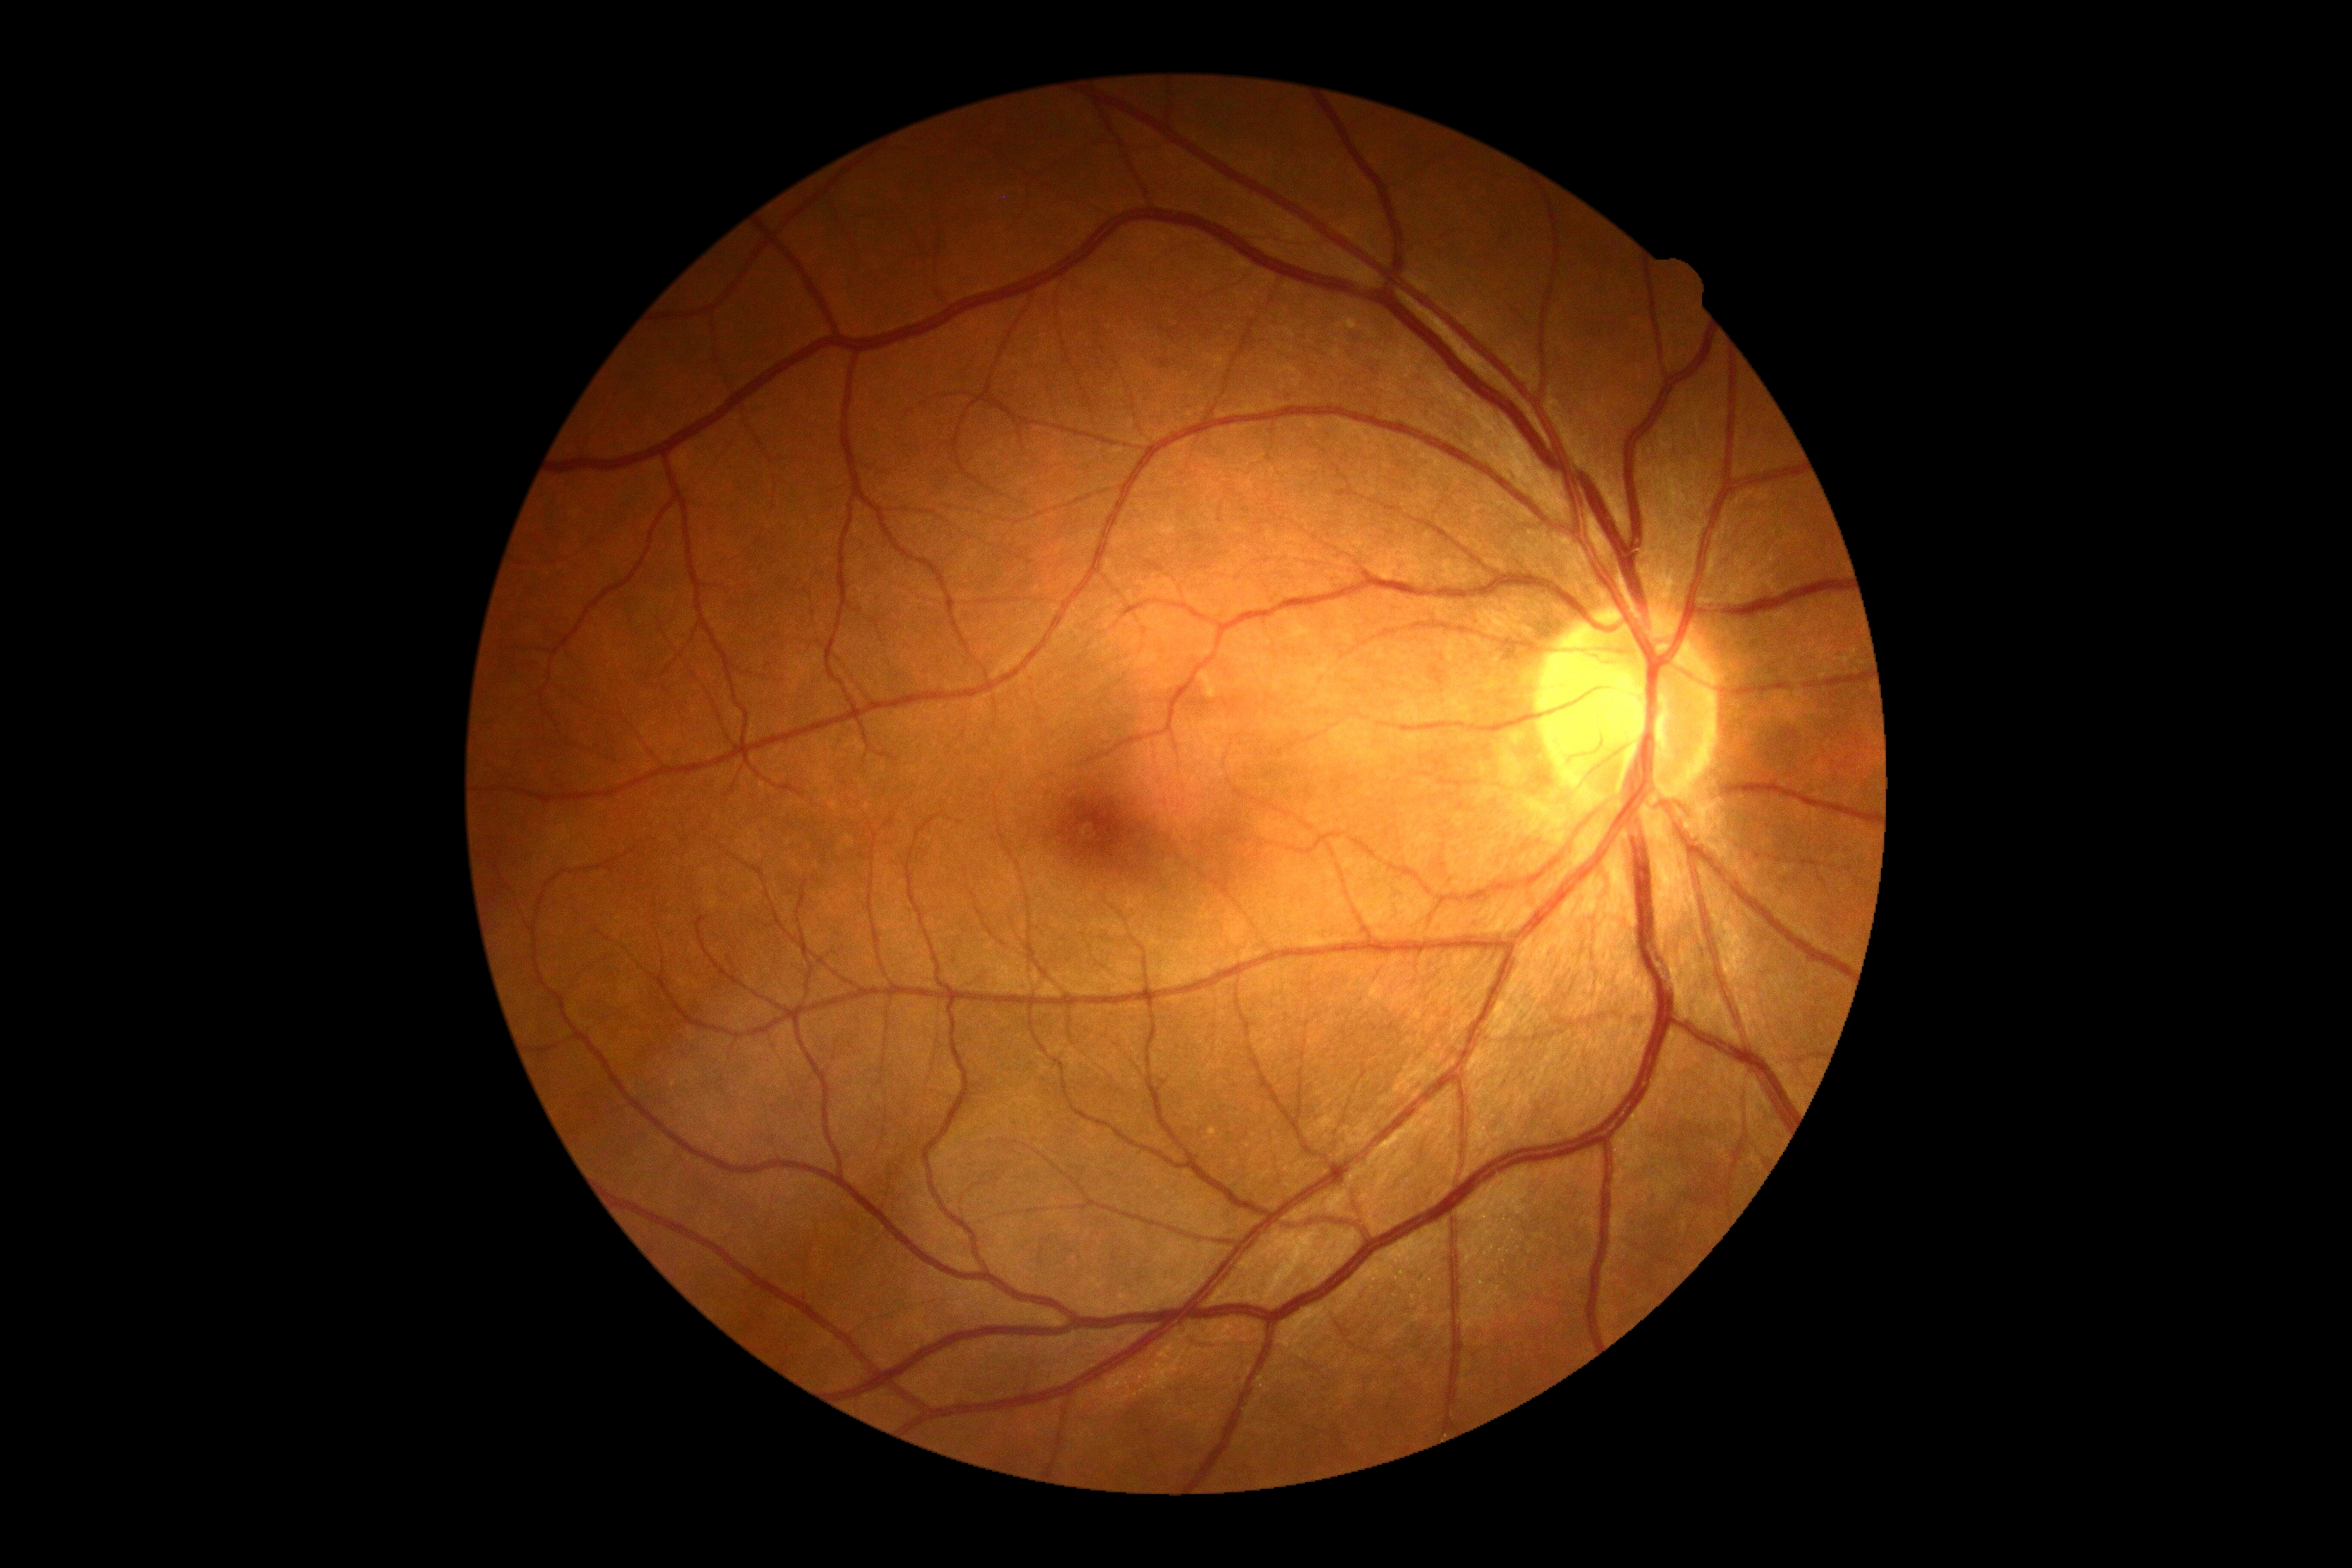

• DR severity — grade 0 (no apparent retinopathy) — no visible signs of diabetic retinopathy